45° field of view · NIDEK AFC-230 fundus camera — 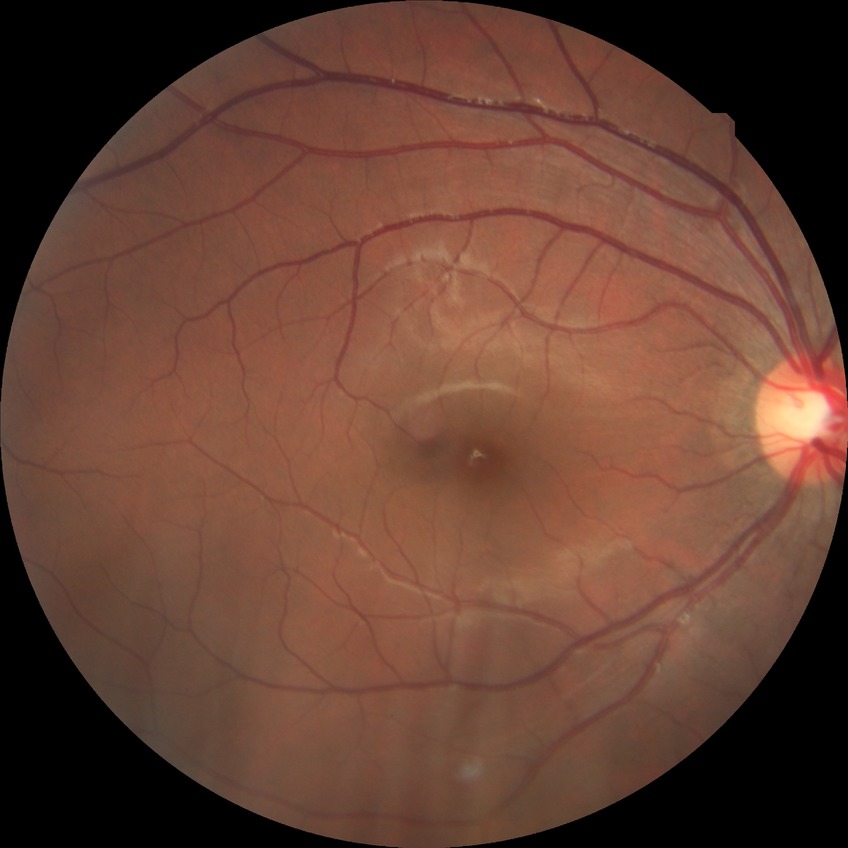
Modified Davis grading: no diabetic retinopathy.